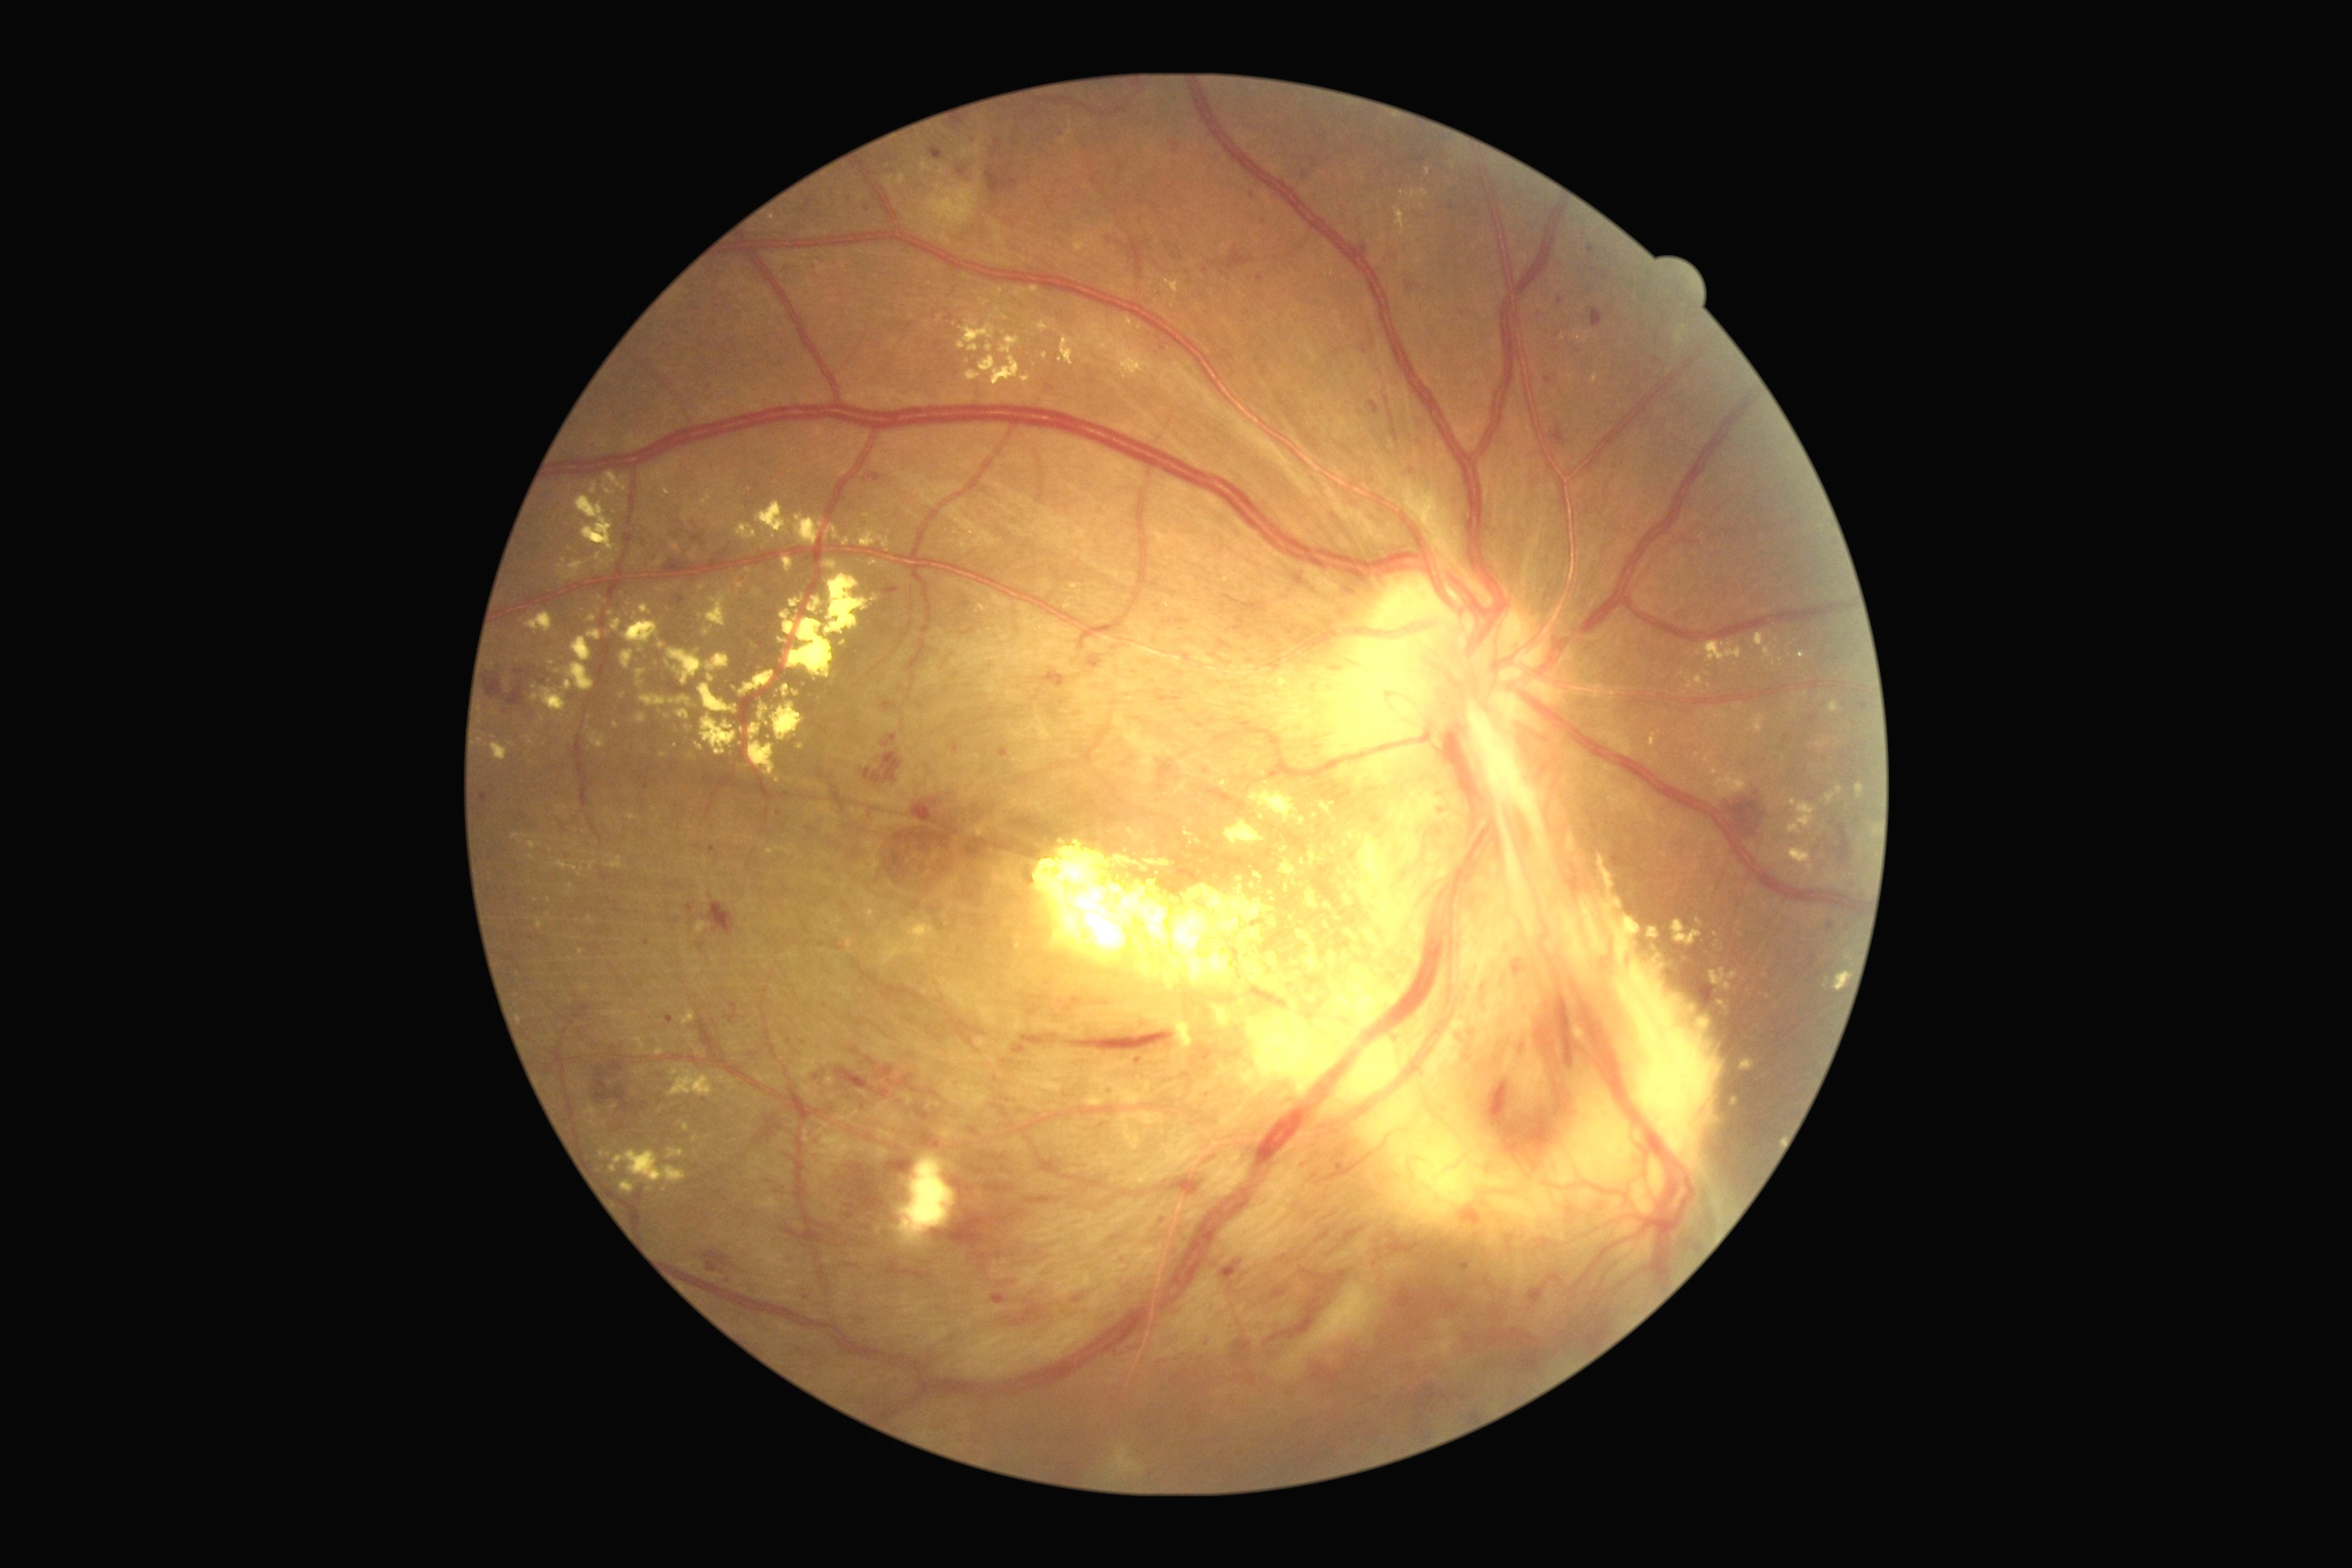

partial: true
dr_grade: 4
dr_grade_name: PDR
lesions:
  ex:
    - {"left": 1348, "top": 832, "right": 1364, "bottom": 841}
    - {"left": 1302, "top": 859, "right": 1306, "bottom": 867}
    - {"left": 1647, "top": 928, "right": 1661, "bottom": 941}
    - {"left": 1280, "top": 847, "right": 1289, "bottom": 854}
    - {"left": 620, "top": 1181, "right": 636, "bottom": 1195}
    - {"left": 591, "top": 484, "right": 598, "bottom": 496}
    - {"left": 611, "top": 1150, "right": 687, "bottom": 1184}
    - {"left": 1244, "top": 926, "right": 1264, "bottom": 943}
    - {"left": 740, "top": 671, "right": 774, "bottom": 696}
    - {"left": 1393, "top": 208, "right": 1407, "bottom": 237}
    - {"left": 760, "top": 705, "right": 769, "bottom": 720}
    - {"left": 692, "top": 1137, "right": 700, "bottom": 1142}
    - {"left": 772, "top": 703, "right": 805, "bottom": 741}
    - {"left": 663, "top": 485, "right": 671, "bottom": 496}
    - {"left": 654, "top": 562, "right": 663, "bottom": 567}
  ex_small_centers:
    - (549,901)
    - (796,695)
    - (1384,238)
    - (1111,382)